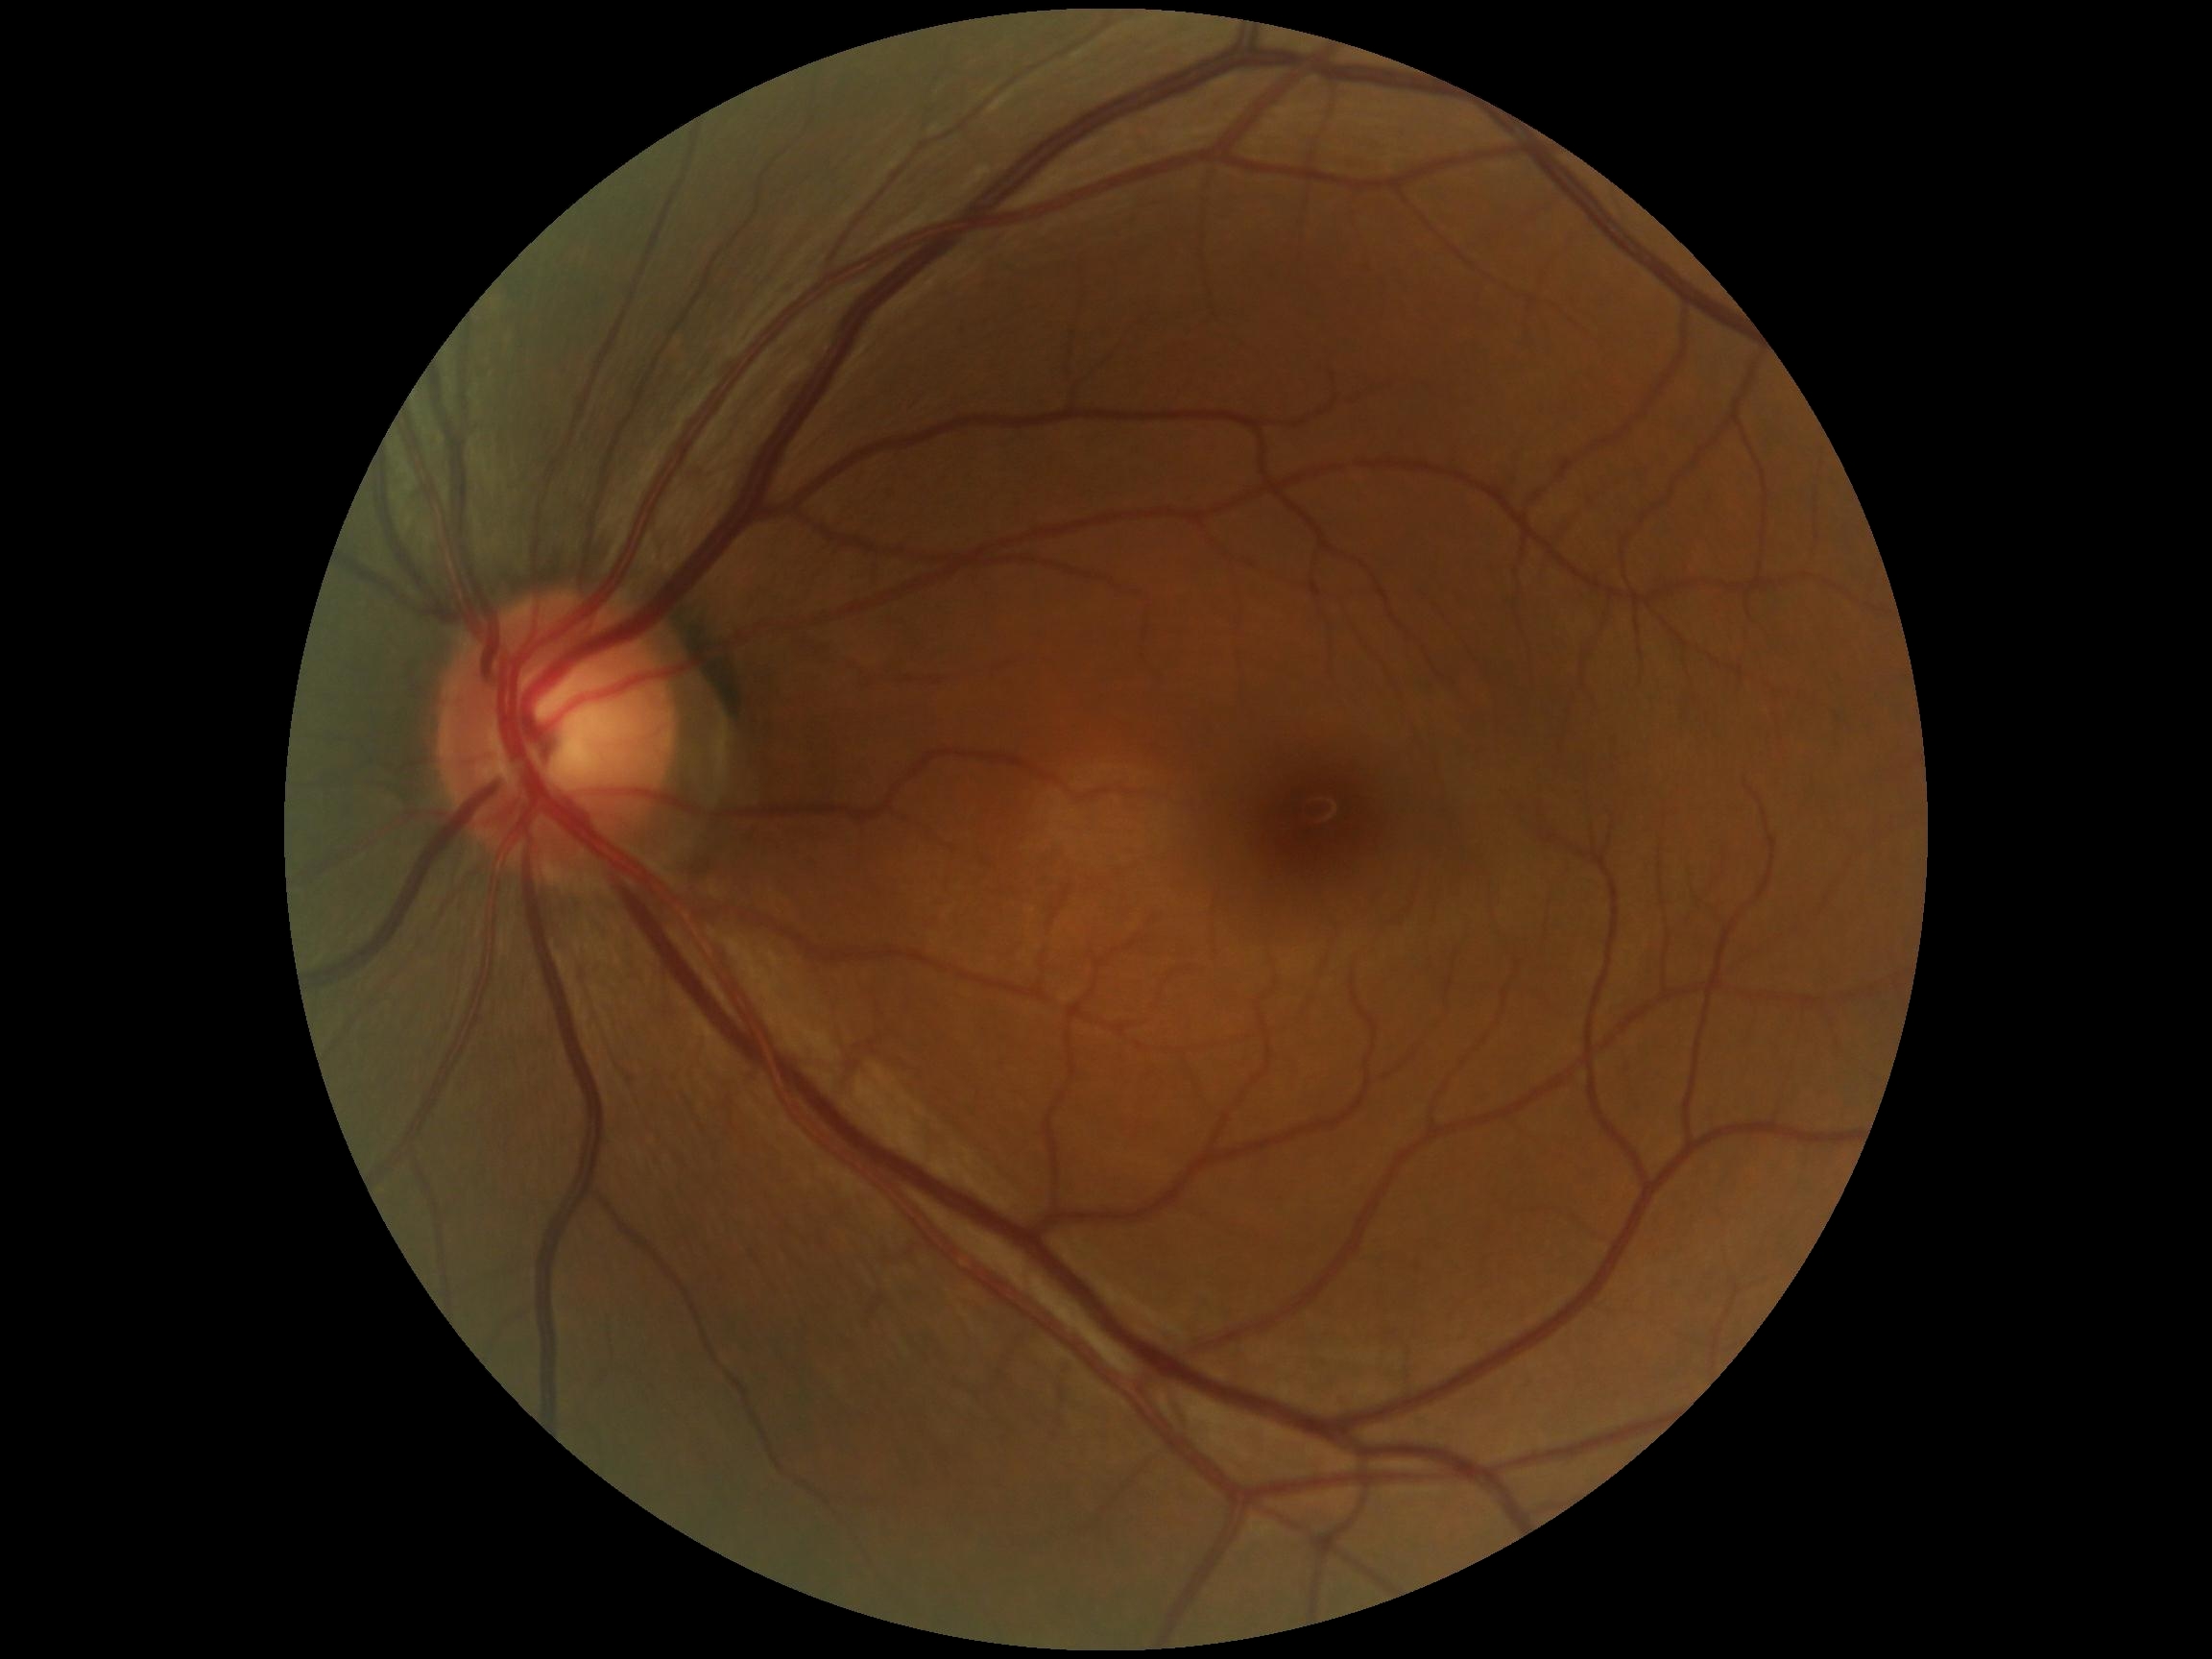
DR stage = no apparent retinopathy (grade 0) — no visible signs of diabetic retinopathy.